45° field of view · NIDEK AFC-230 fundus camera: 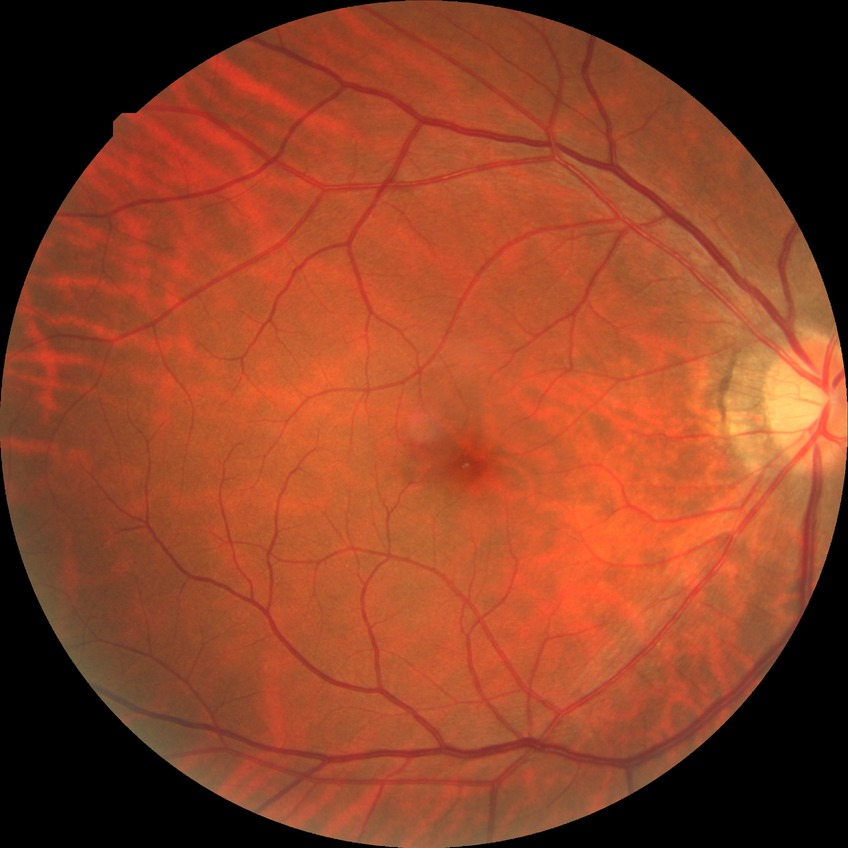
diabetic retinopathy (DR)=NDR (no diabetic retinopathy).